CFP. Camera: NIDEK AFC-230. 848 by 848 pixels:
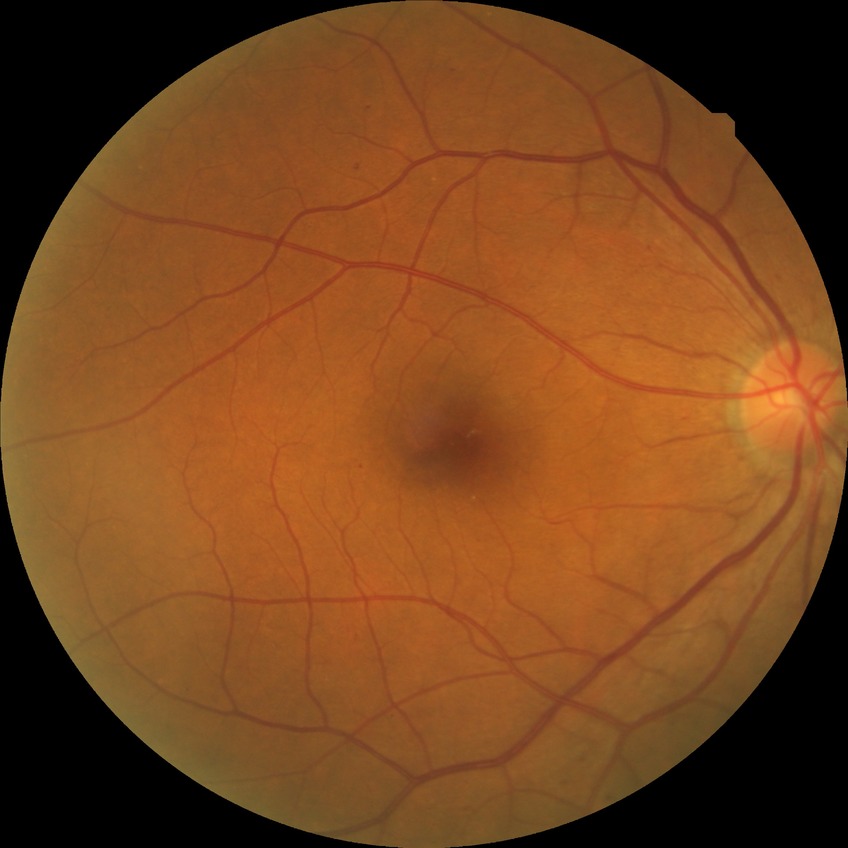
DR class = non-proliferative diabetic retinopathy, diabetic retinopathy (DR) = simple diabetic retinopathy (SDR).